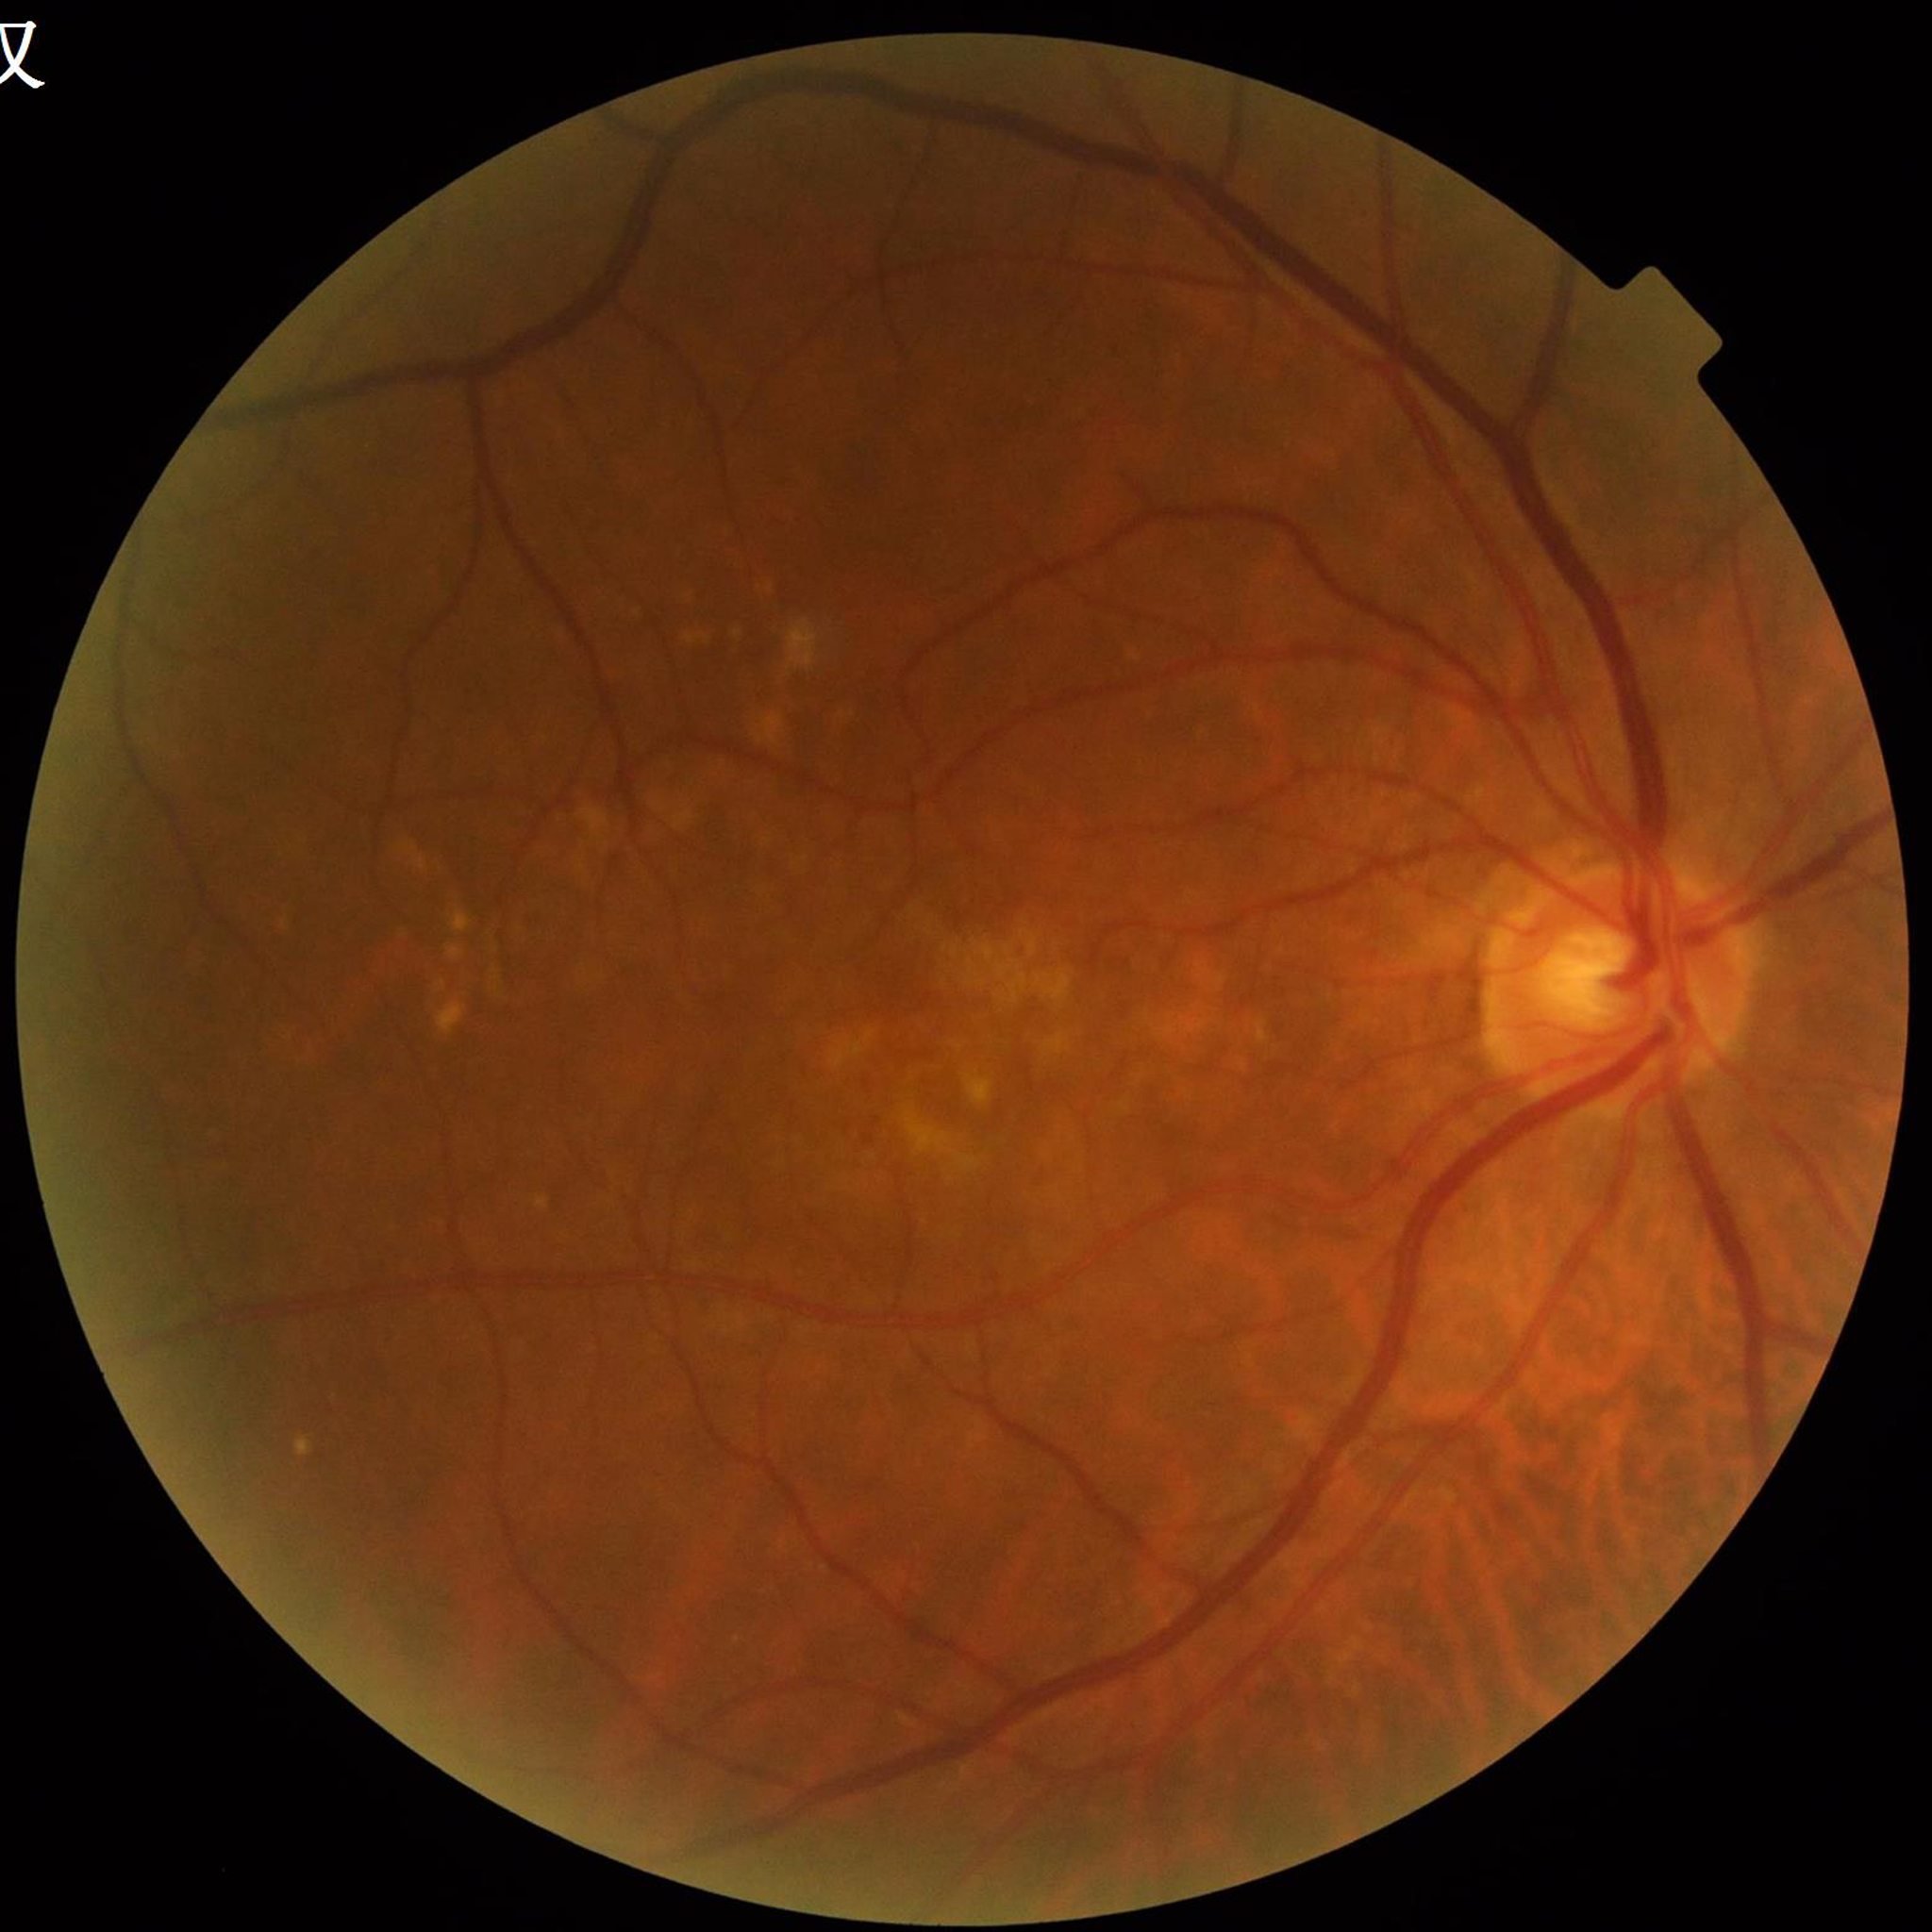 diagnosis: AMD
image_quality: illumination and color satisfactory, no blur, contrast adequate